1932x1910px. Color fundus photograph
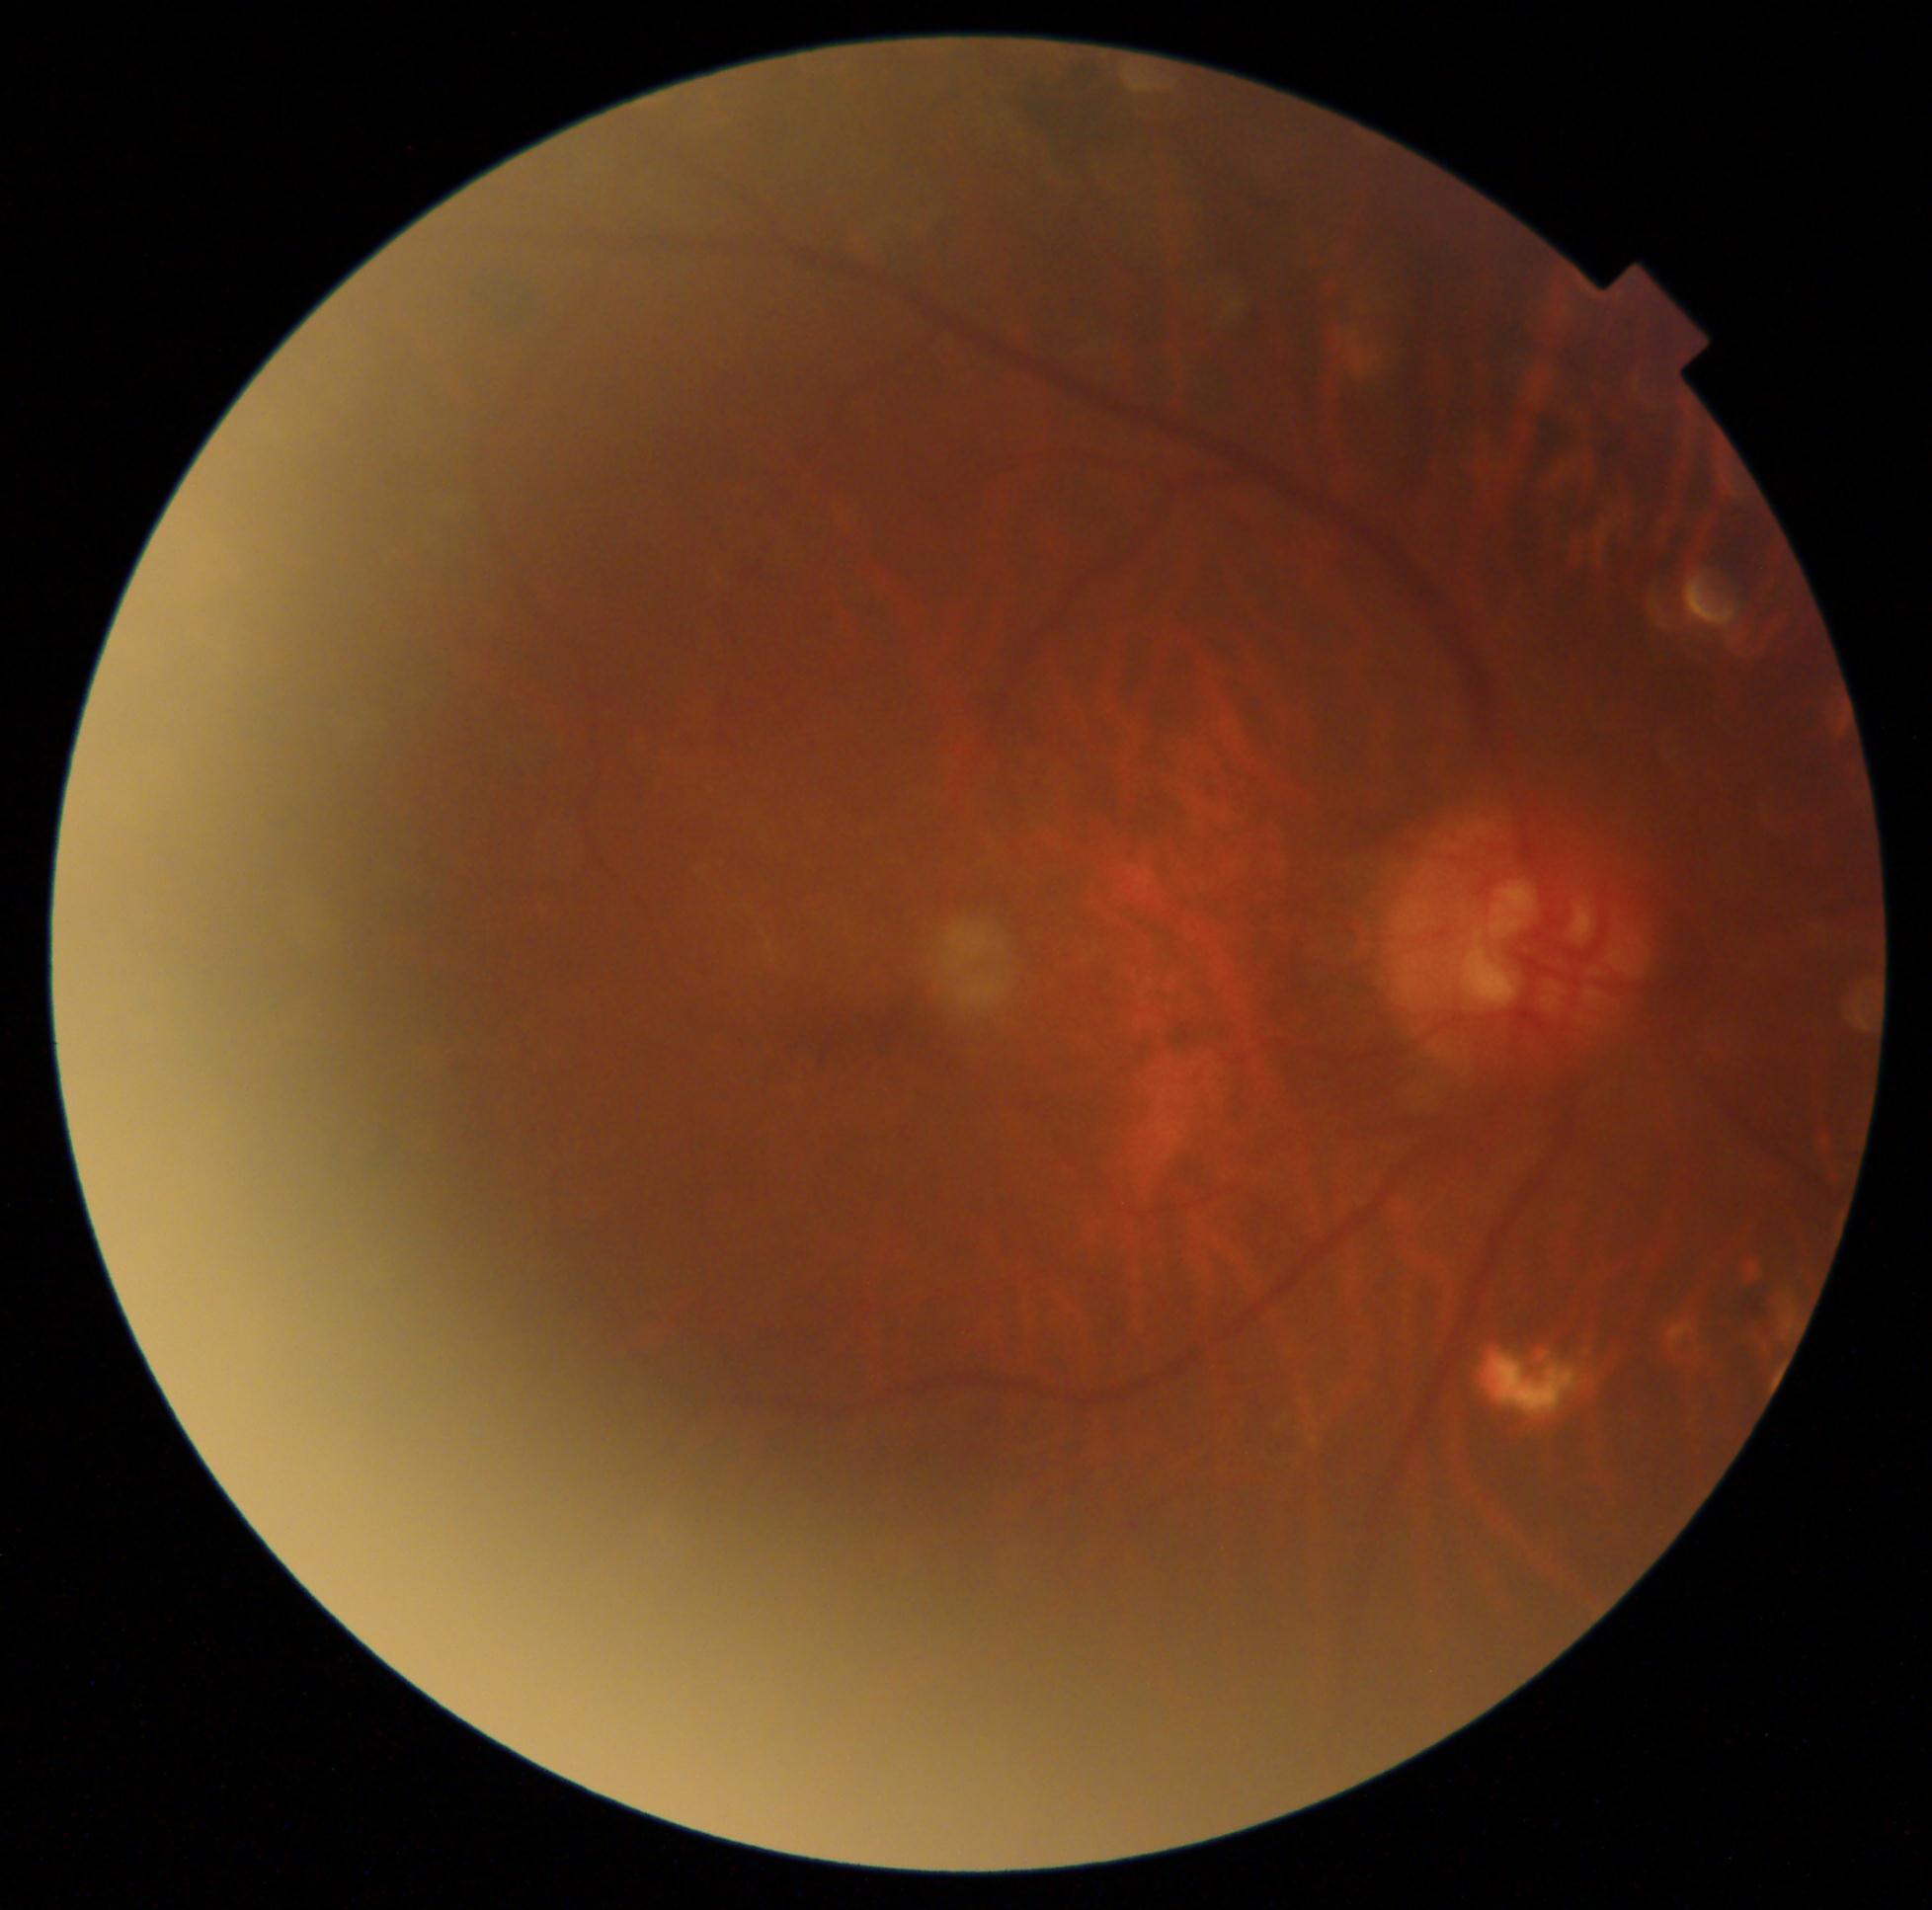
retinopathy grade=4 (PDR).